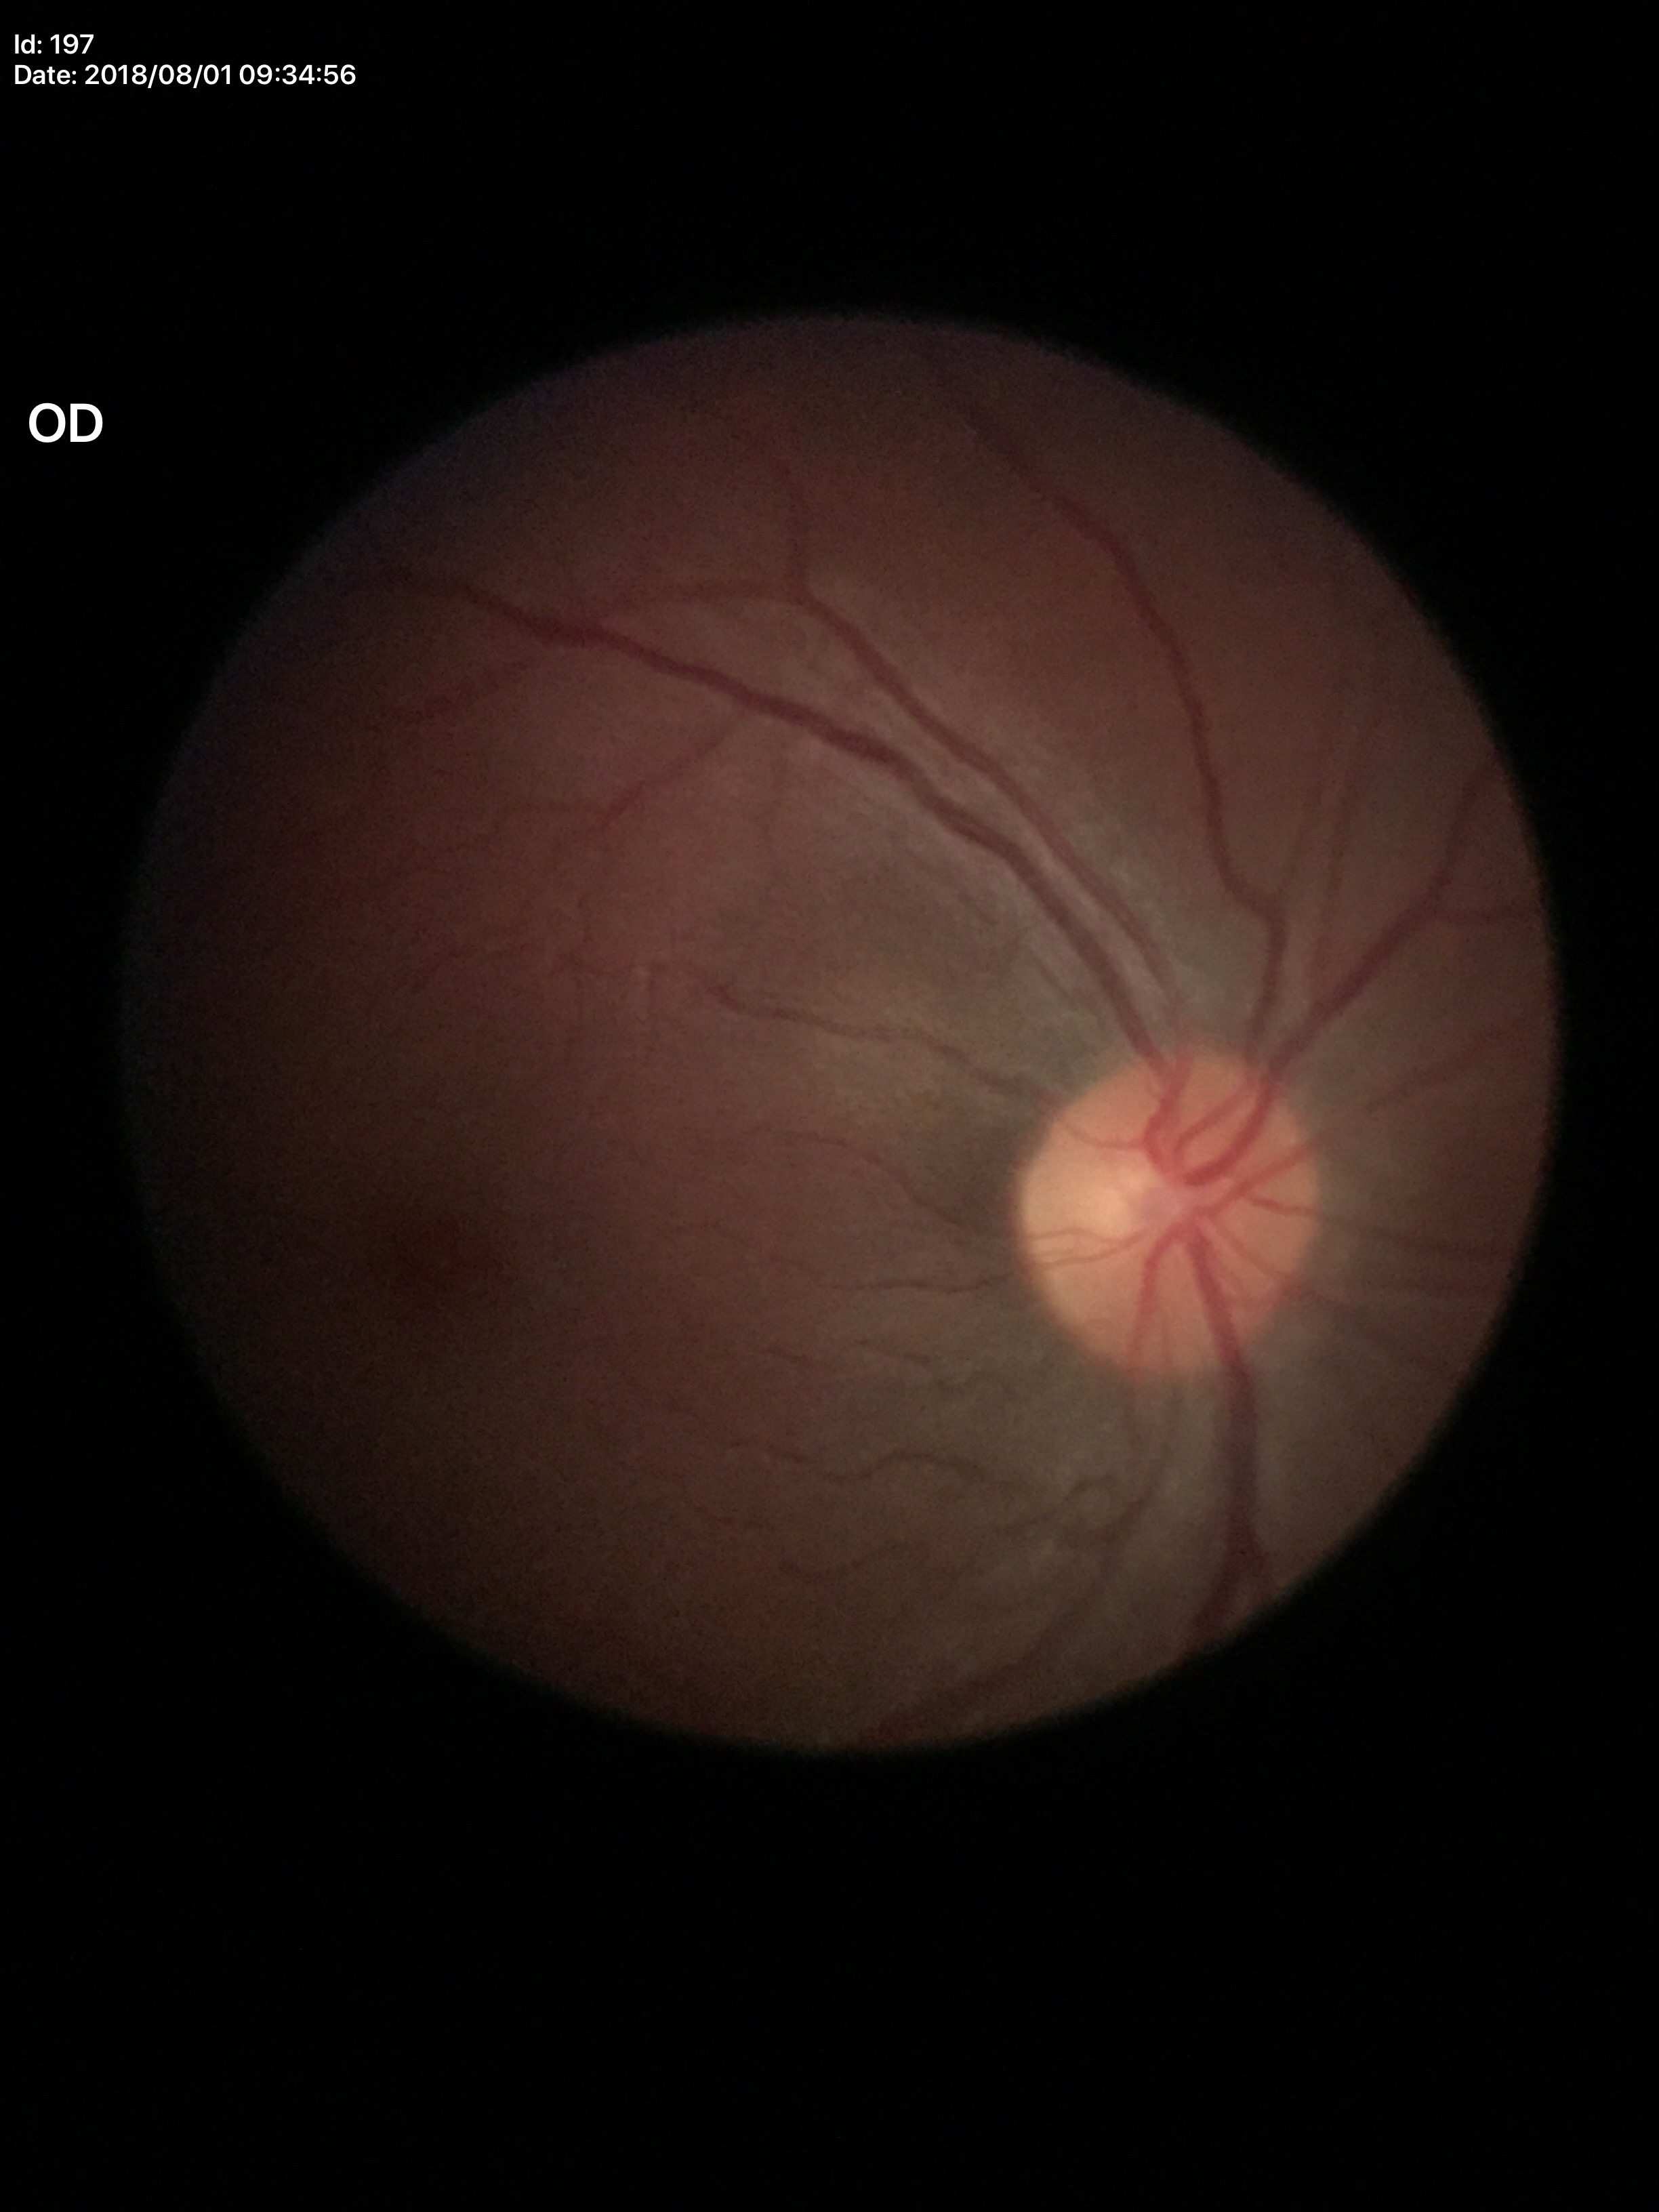

Vertical CDR: 0.40. No evidence of glaucoma.